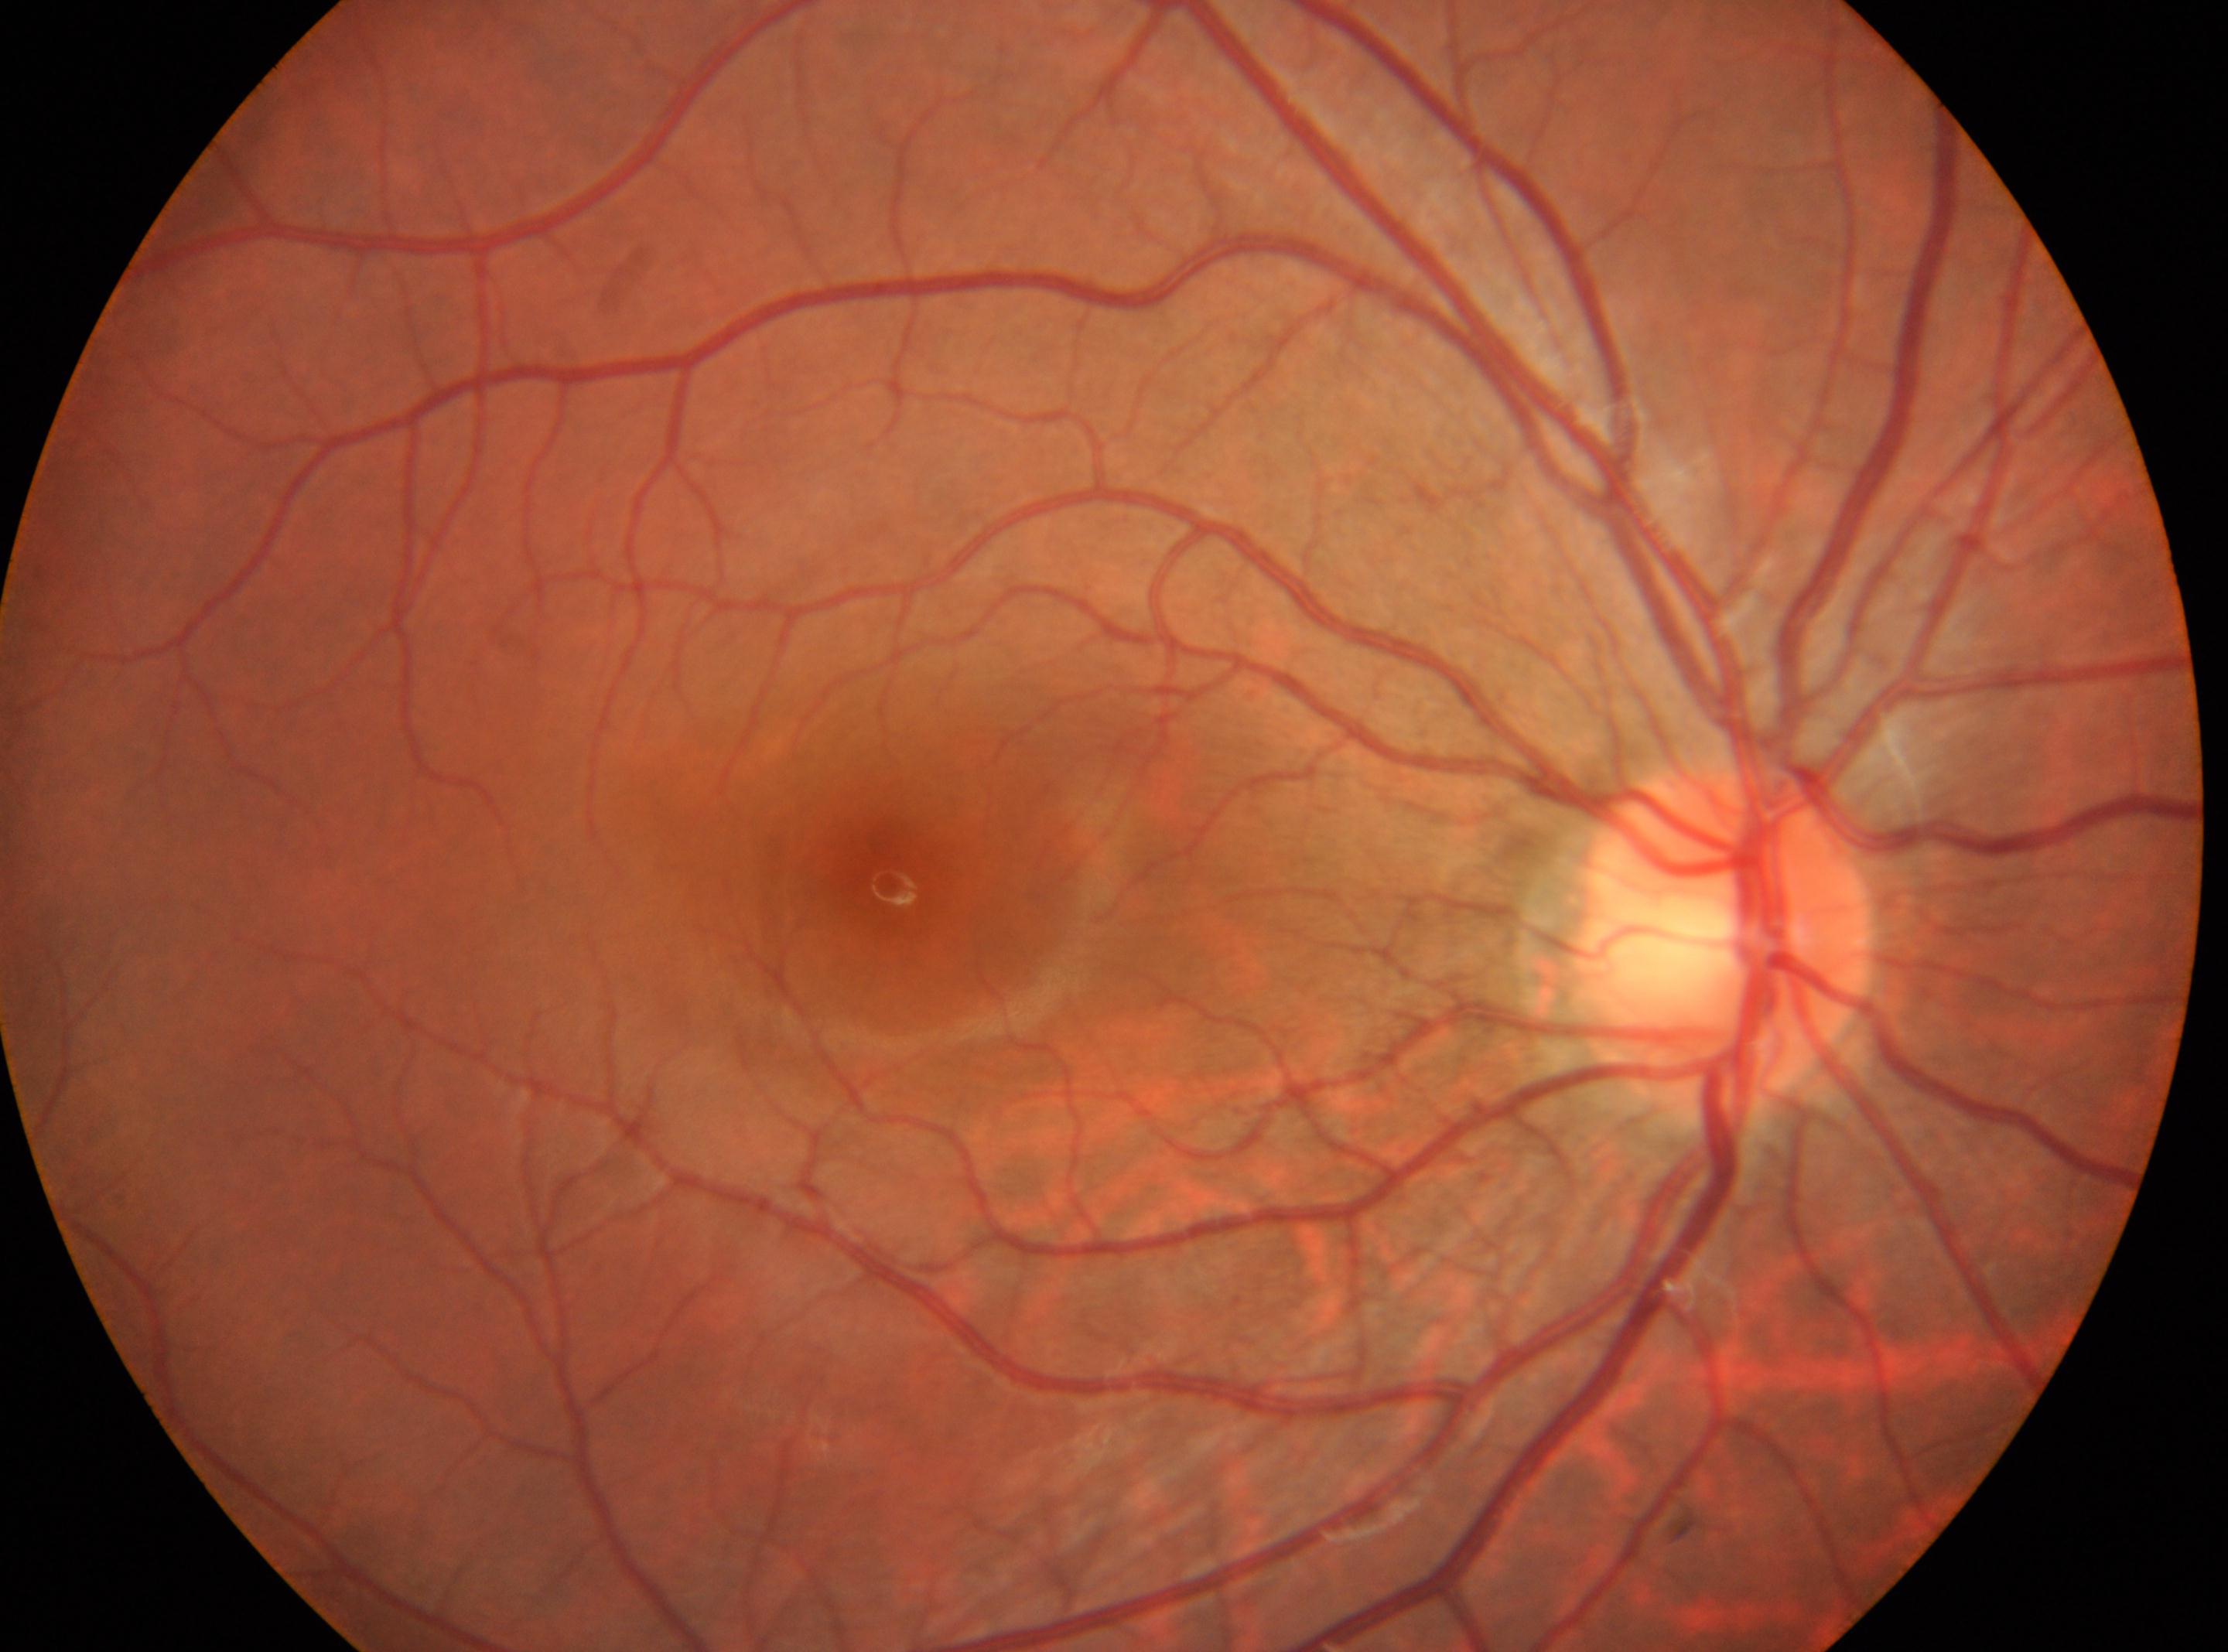 This is the right eye. Fovea centralis: (890,885). Optic disc located at (1723,934). DR severity: grade 0 — no visible signs of diabetic retinopathy.